45-degree field of view, fundus photo: 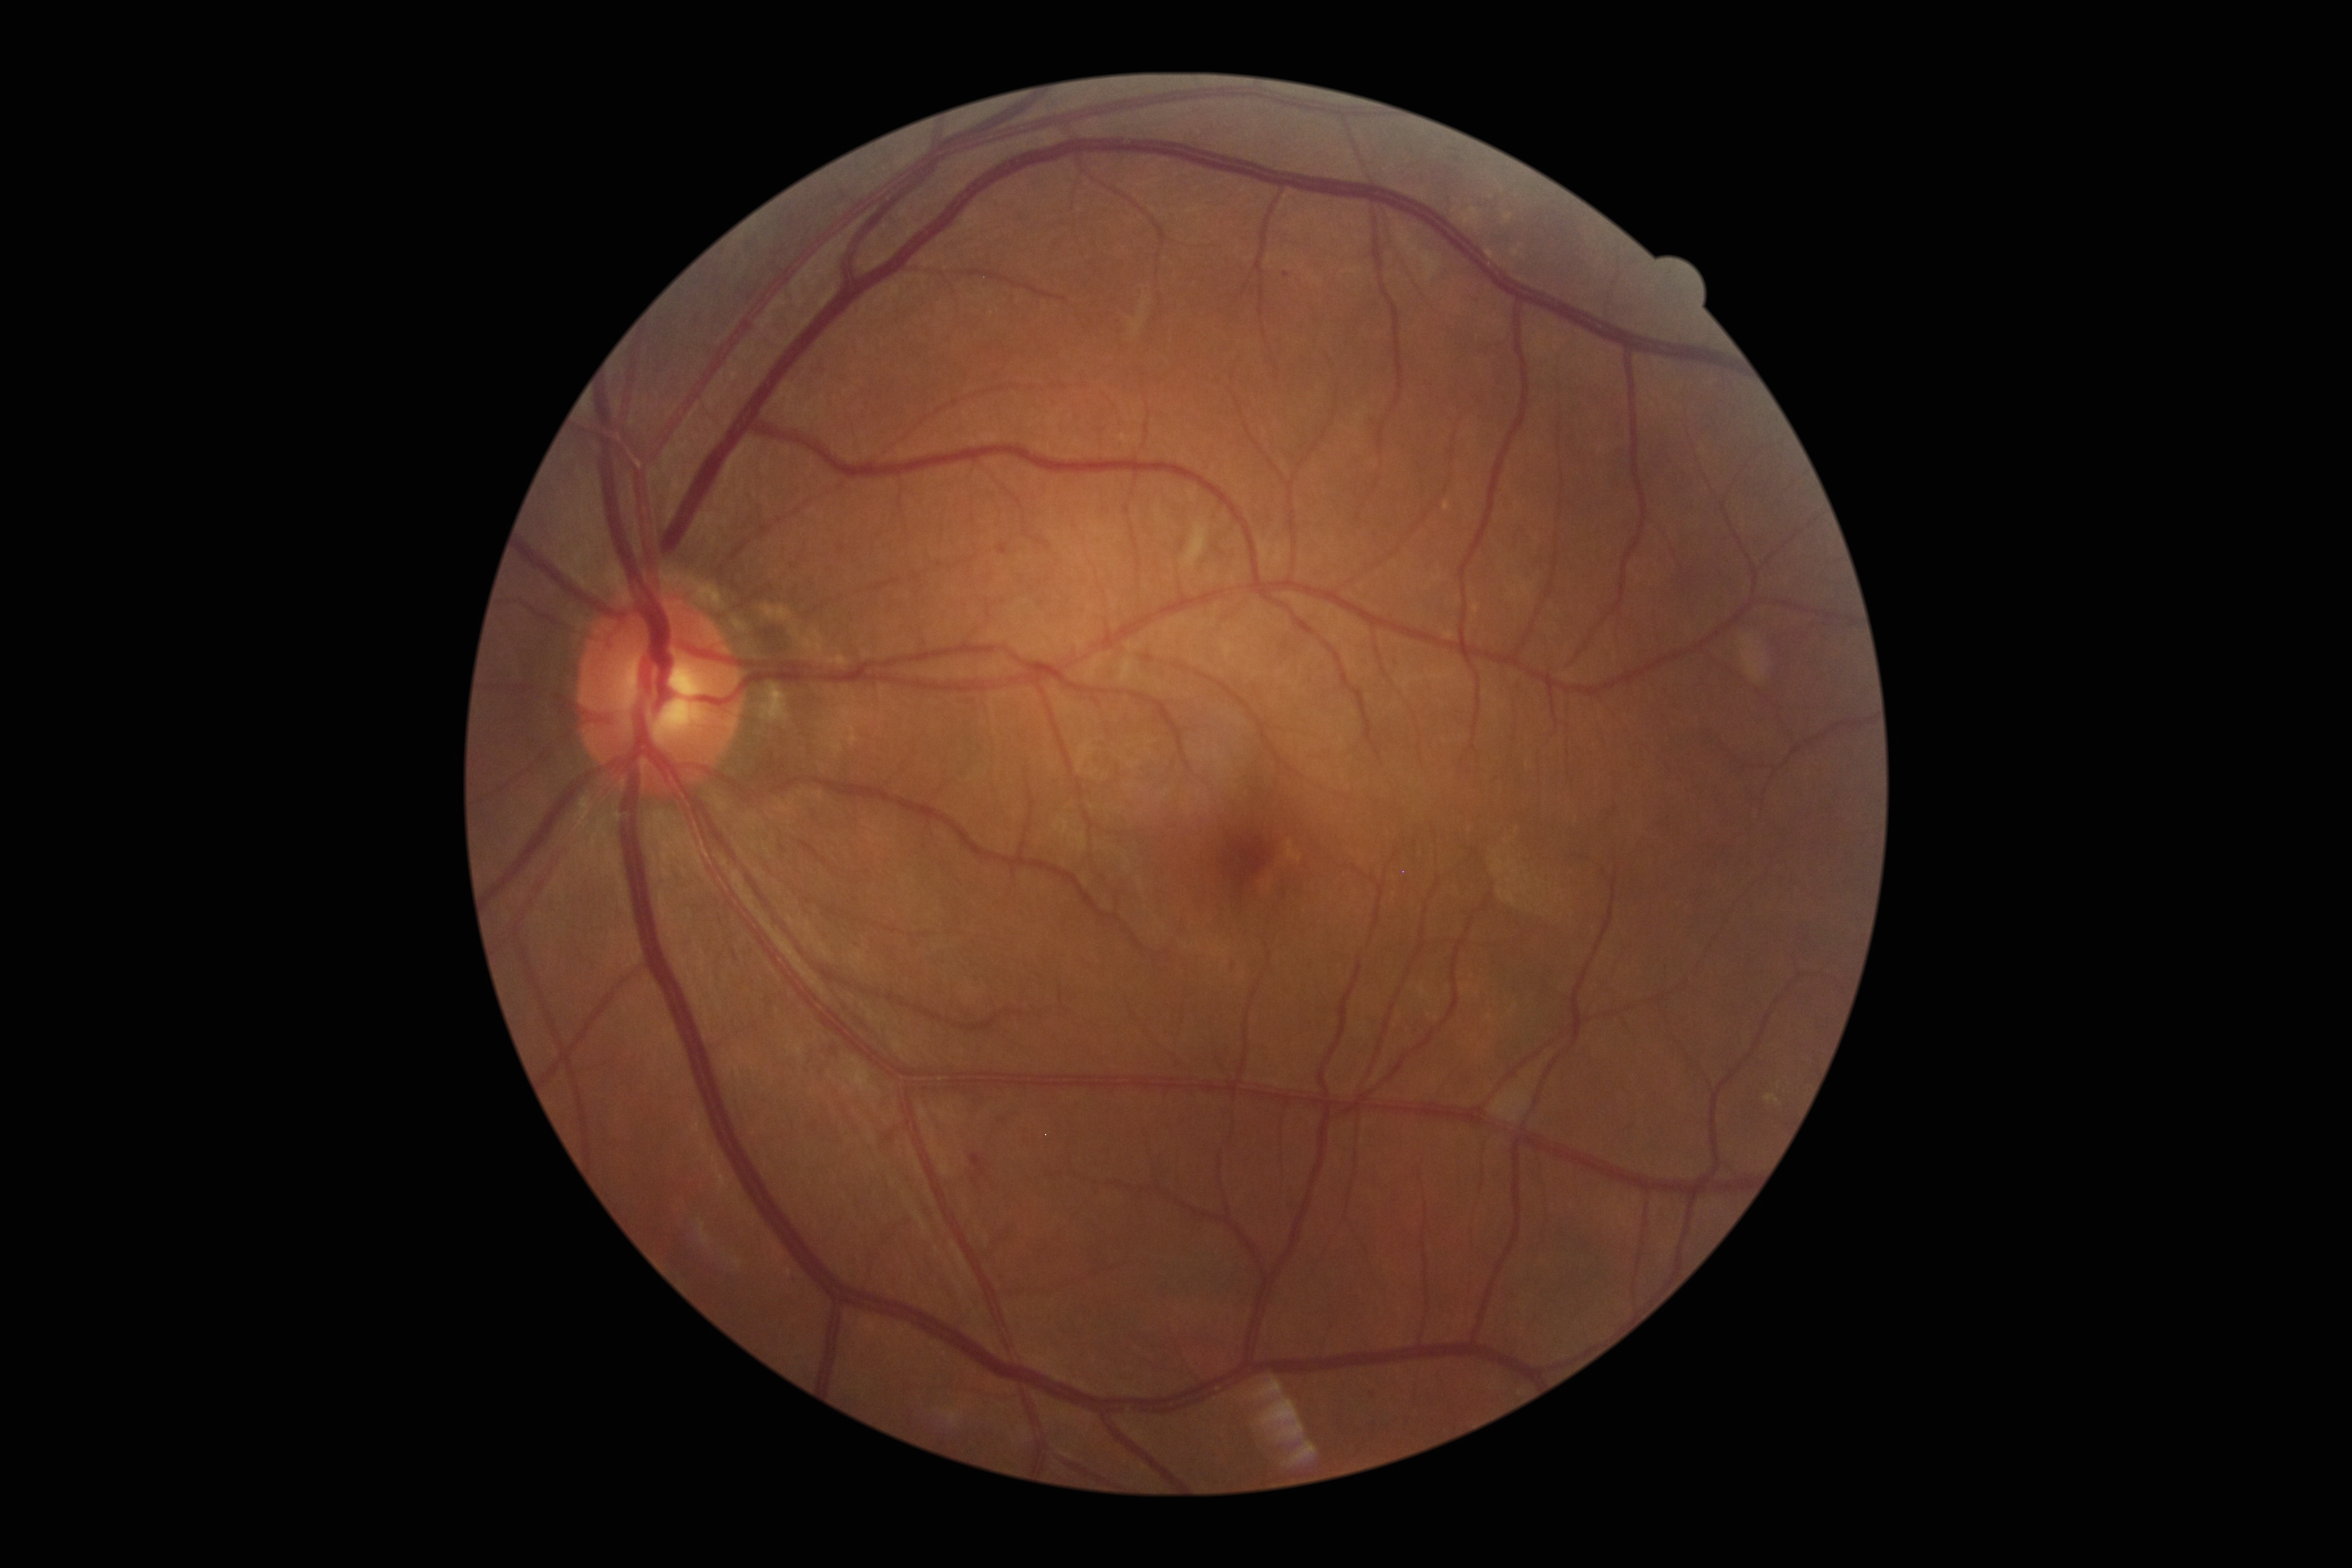

- diabetic retinopathy (DR): moderate NPDR (grade 2)